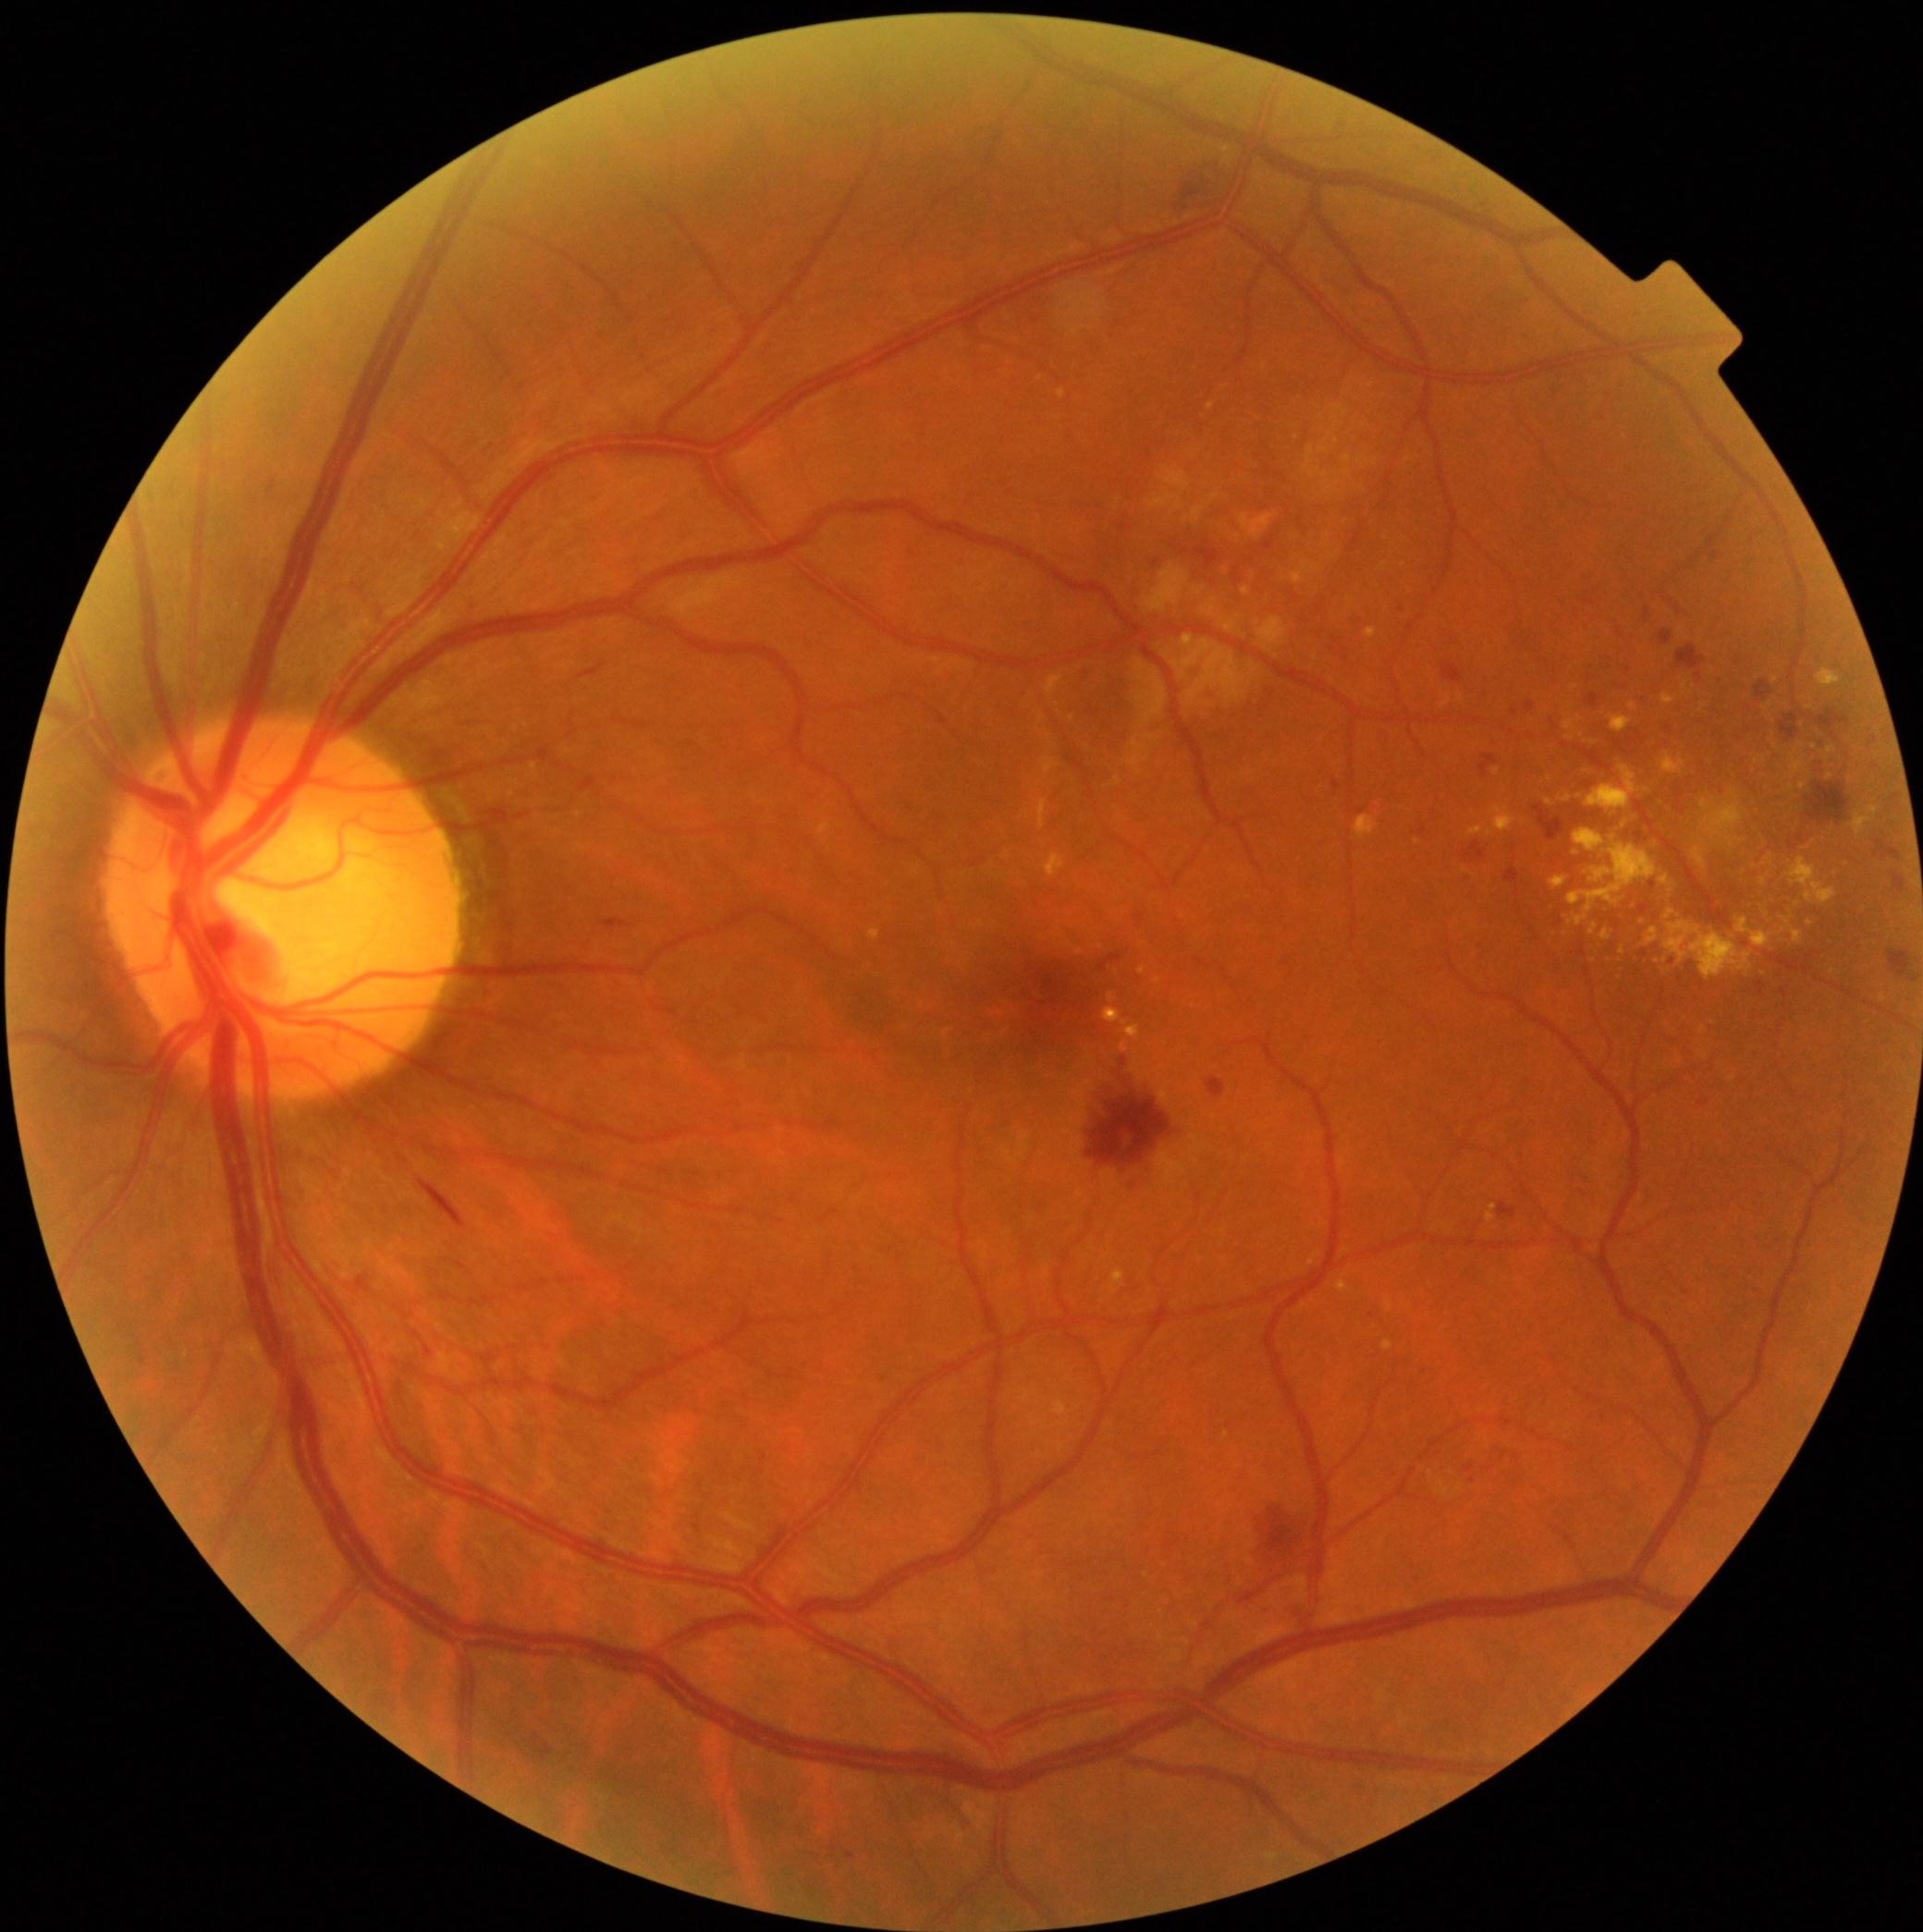
Retinopathy grade is 2/4
Lesions identified (partial list):
hemorrhages (more not shown): bbox=[1889, 951, 1911, 979]; bbox=[1208, 1078, 1227, 1099]; bbox=[1470, 842, 1488, 859]; bbox=[1875, 840, 1902, 862]; bbox=[1758, 681, 1772, 700]; bbox=[1676, 645, 1707, 670]; bbox=[419, 1181, 468, 1230]; bbox=[1506, 868, 1519, 884]; bbox=[1256, 1508, 1304, 1571]; bbox=[1660, 632, 1674, 645]; bbox=[1444, 664, 1463, 683]; bbox=[1815, 711, 1851, 741]; bbox=[1480, 756, 1499, 776]
Small hemorrhages near [1469,856]
hard exudates (more not shown): bbox=[1665, 923, 1754, 981]; bbox=[1869, 809, 1879, 814]; bbox=[1549, 878, 1568, 889]; bbox=[1052, 1400, 1070, 1418]; bbox=[1468, 827, 1484, 837]; bbox=[1120, 1043, 1129, 1054]; bbox=[1564, 718, 1577, 732]; bbox=[1133, 1056, 1152, 1082]; bbox=[1590, 924, 1598, 935]; bbox=[1105, 1009, 1141, 1041]; bbox=[1661, 756, 1686, 775]; bbox=[1382, 1340, 1393, 1352]
Small hard exudates near [1764,883]; [1447,703]; [1143,971]; [1158,981]; [1815,749]; [1767,709]; [1883,998]
soft exudates (more not shown): bbox=[1185, 507, 1206, 521]; bbox=[1191, 587, 1206, 597]; bbox=[1221, 618, 1242, 634]; bbox=[1305, 406, 1351, 479]; bbox=[1343, 454, 1354, 466]; bbox=[1161, 470, 1191, 492]; bbox=[1256, 619, 1287, 653]; bbox=[1333, 439, 1339, 450]
Small soft exudates near [1215,498]; [1364,427]
microaneurysms (more not shown): bbox=[846, 1854, 855, 1860]; bbox=[1466, 1466, 1474, 1473]; bbox=[1137, 915, 1145, 924]; bbox=[1333, 782, 1341, 791]; bbox=[1234, 569, 1242, 583]; bbox=[269, 486, 275, 494]; bbox=[1796, 837, 1806, 844]
Small microaneurysms near [1668,731]; [1682,812]; [1504,1458]; [1268,474]; [1473,1482]; [1733,894]; [1514,712]; [1794,848]; [1653,886]